Pediatric retinal photograph (wide-field) · captured with the Clarity RetCam 3 (130° field of view) — 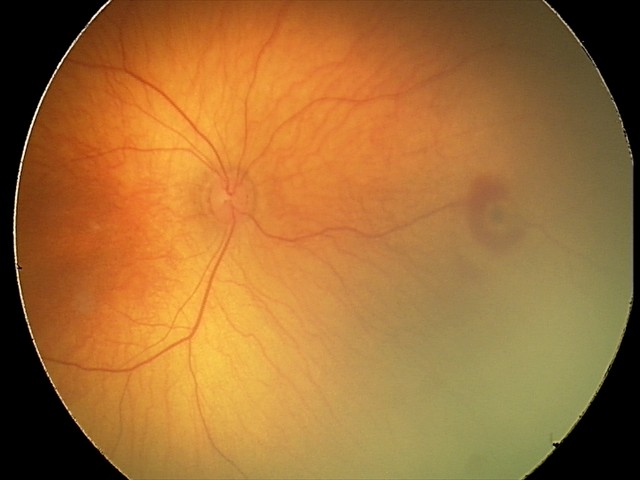

Screening examination consistent with retinal hemorrhages.